Wide-field retinal mosaic image:
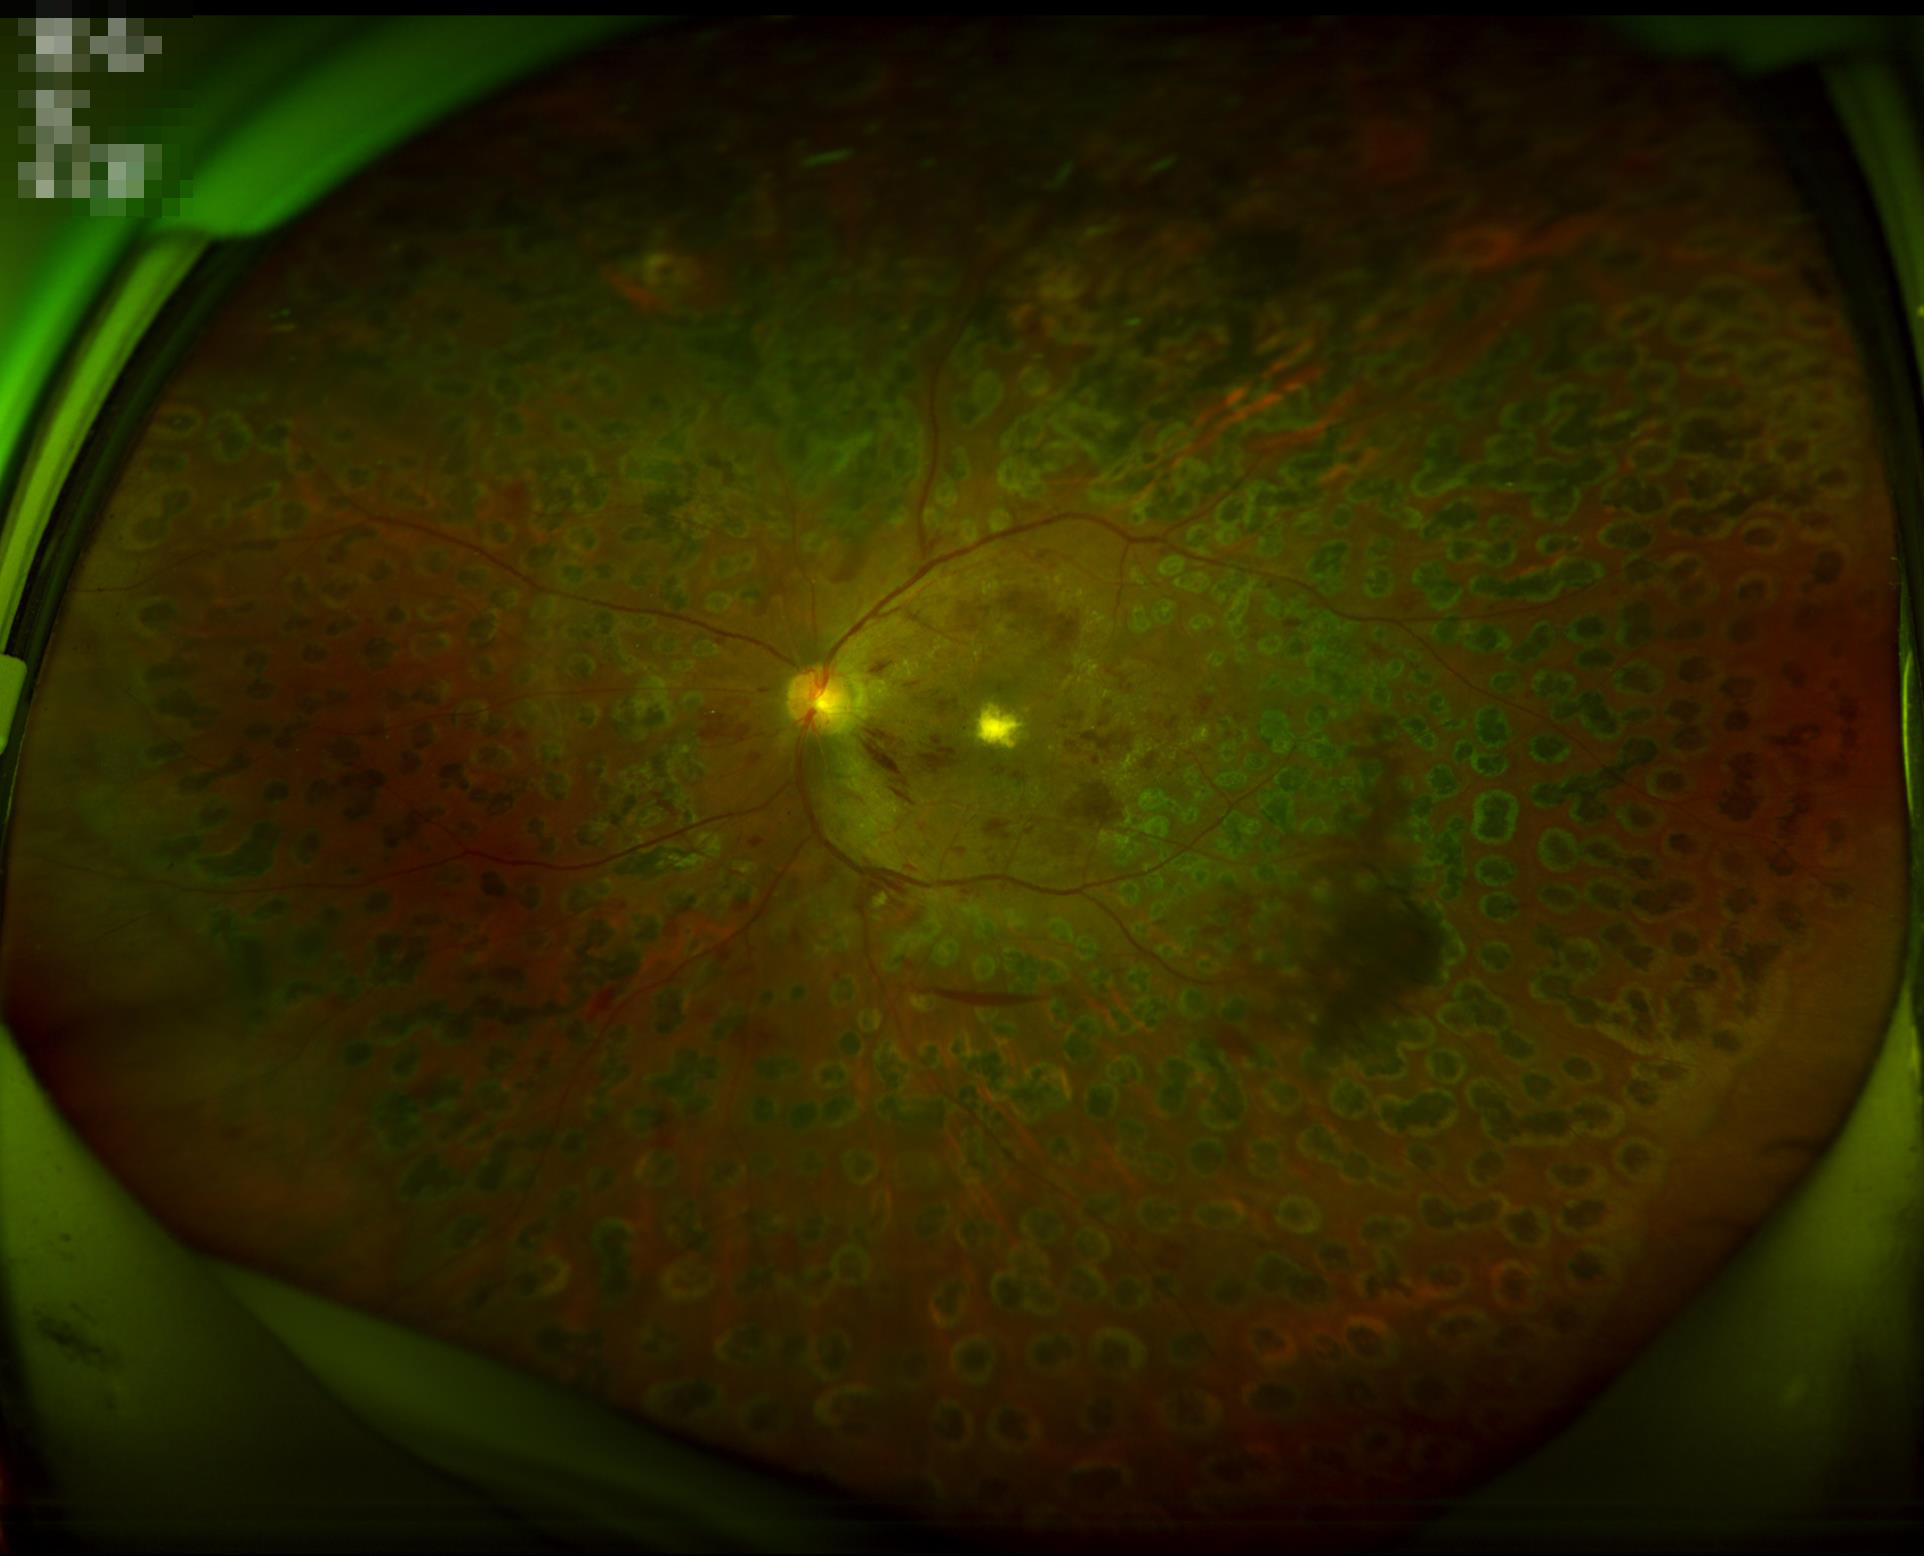

Contrast = vessels and details readily distinguishable | Overall image quality = good, gradable | Illumination = good illumination and color balance | Sharpness = sharp throughout the field.